CFP: 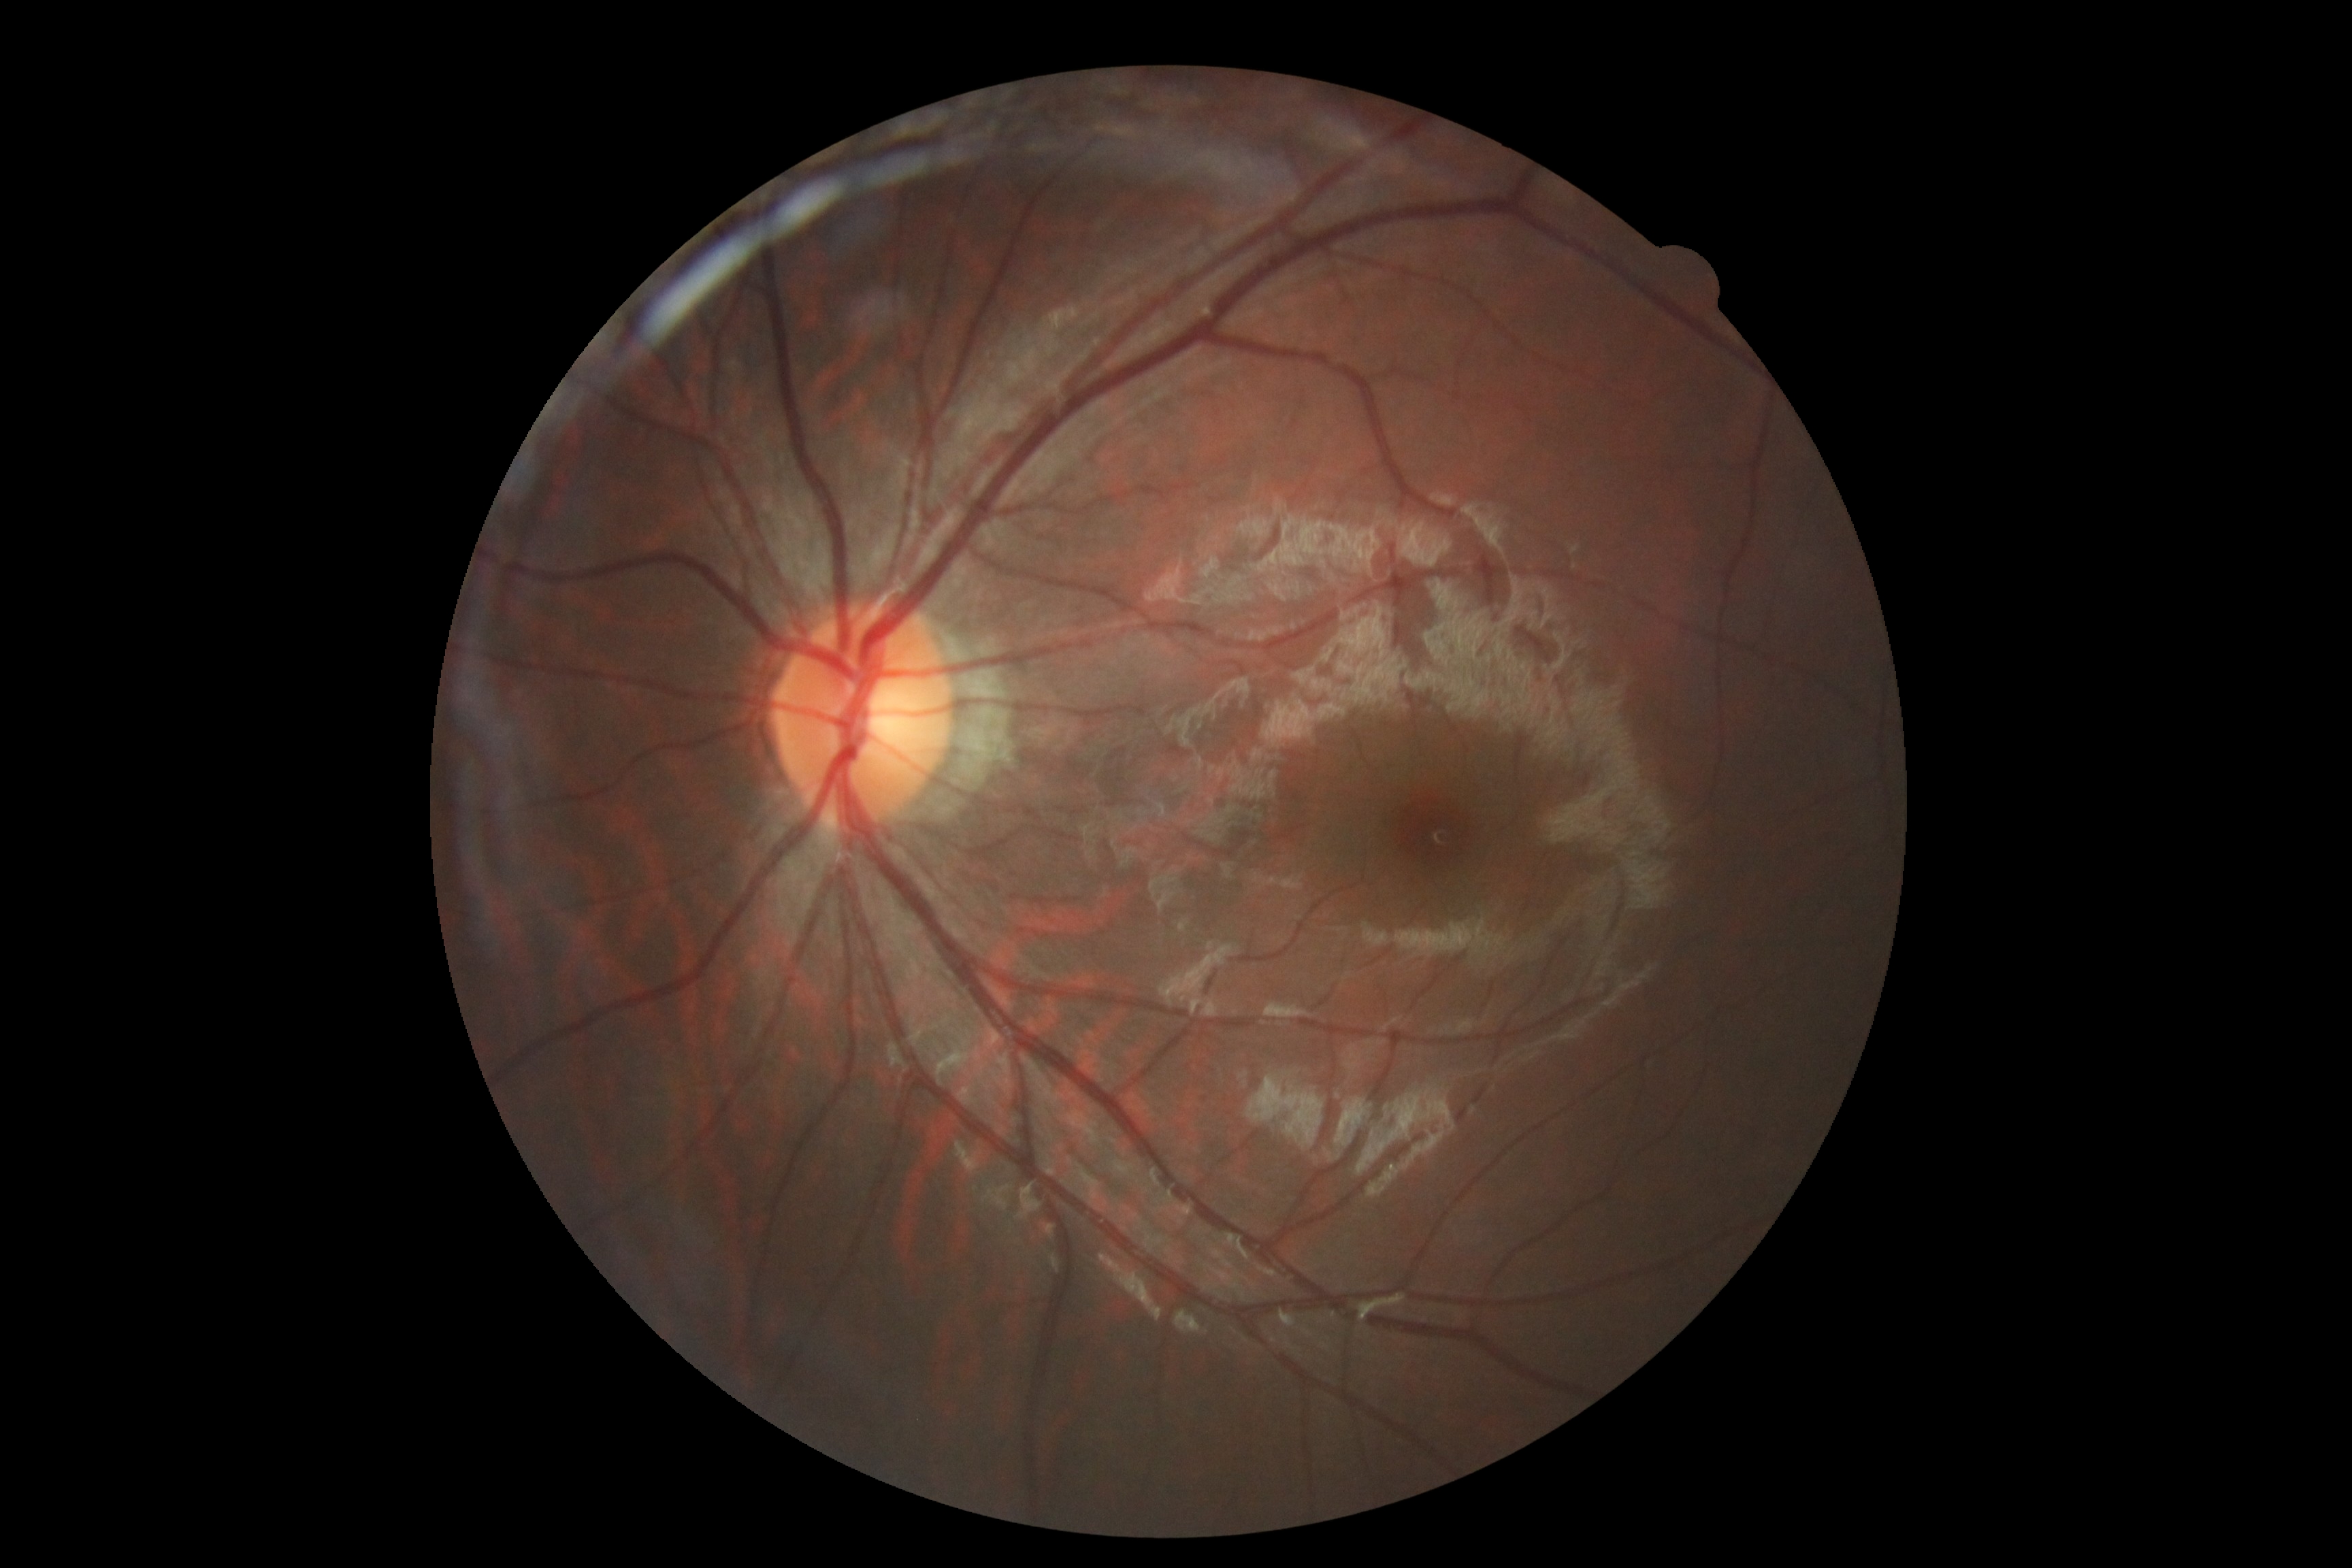
DR stage: no apparent retinopathy (grade 0).
No apparent diabetic retinopathy.